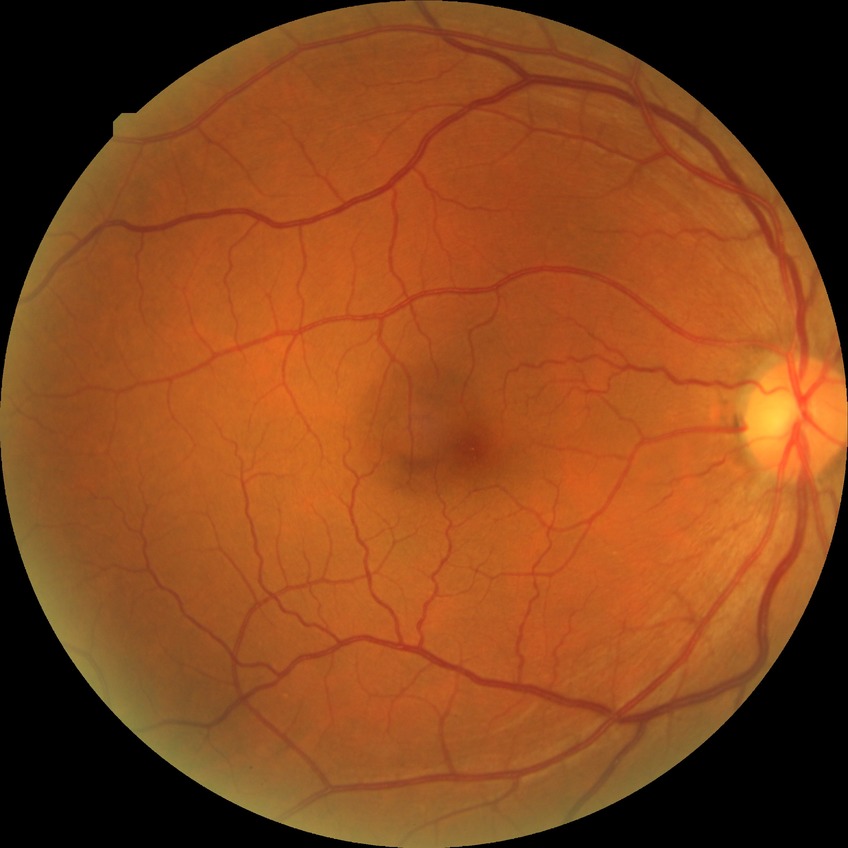

Diabetic retinopathy (DR): NDR (no diabetic retinopathy).